RetCam wide-field infant fundus image: 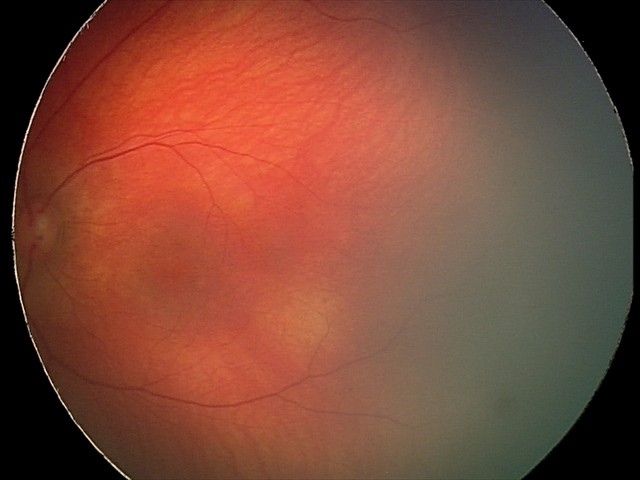

Diagnosis from this screening exam: retinal hemorrhages.